Image size 2048x1536:
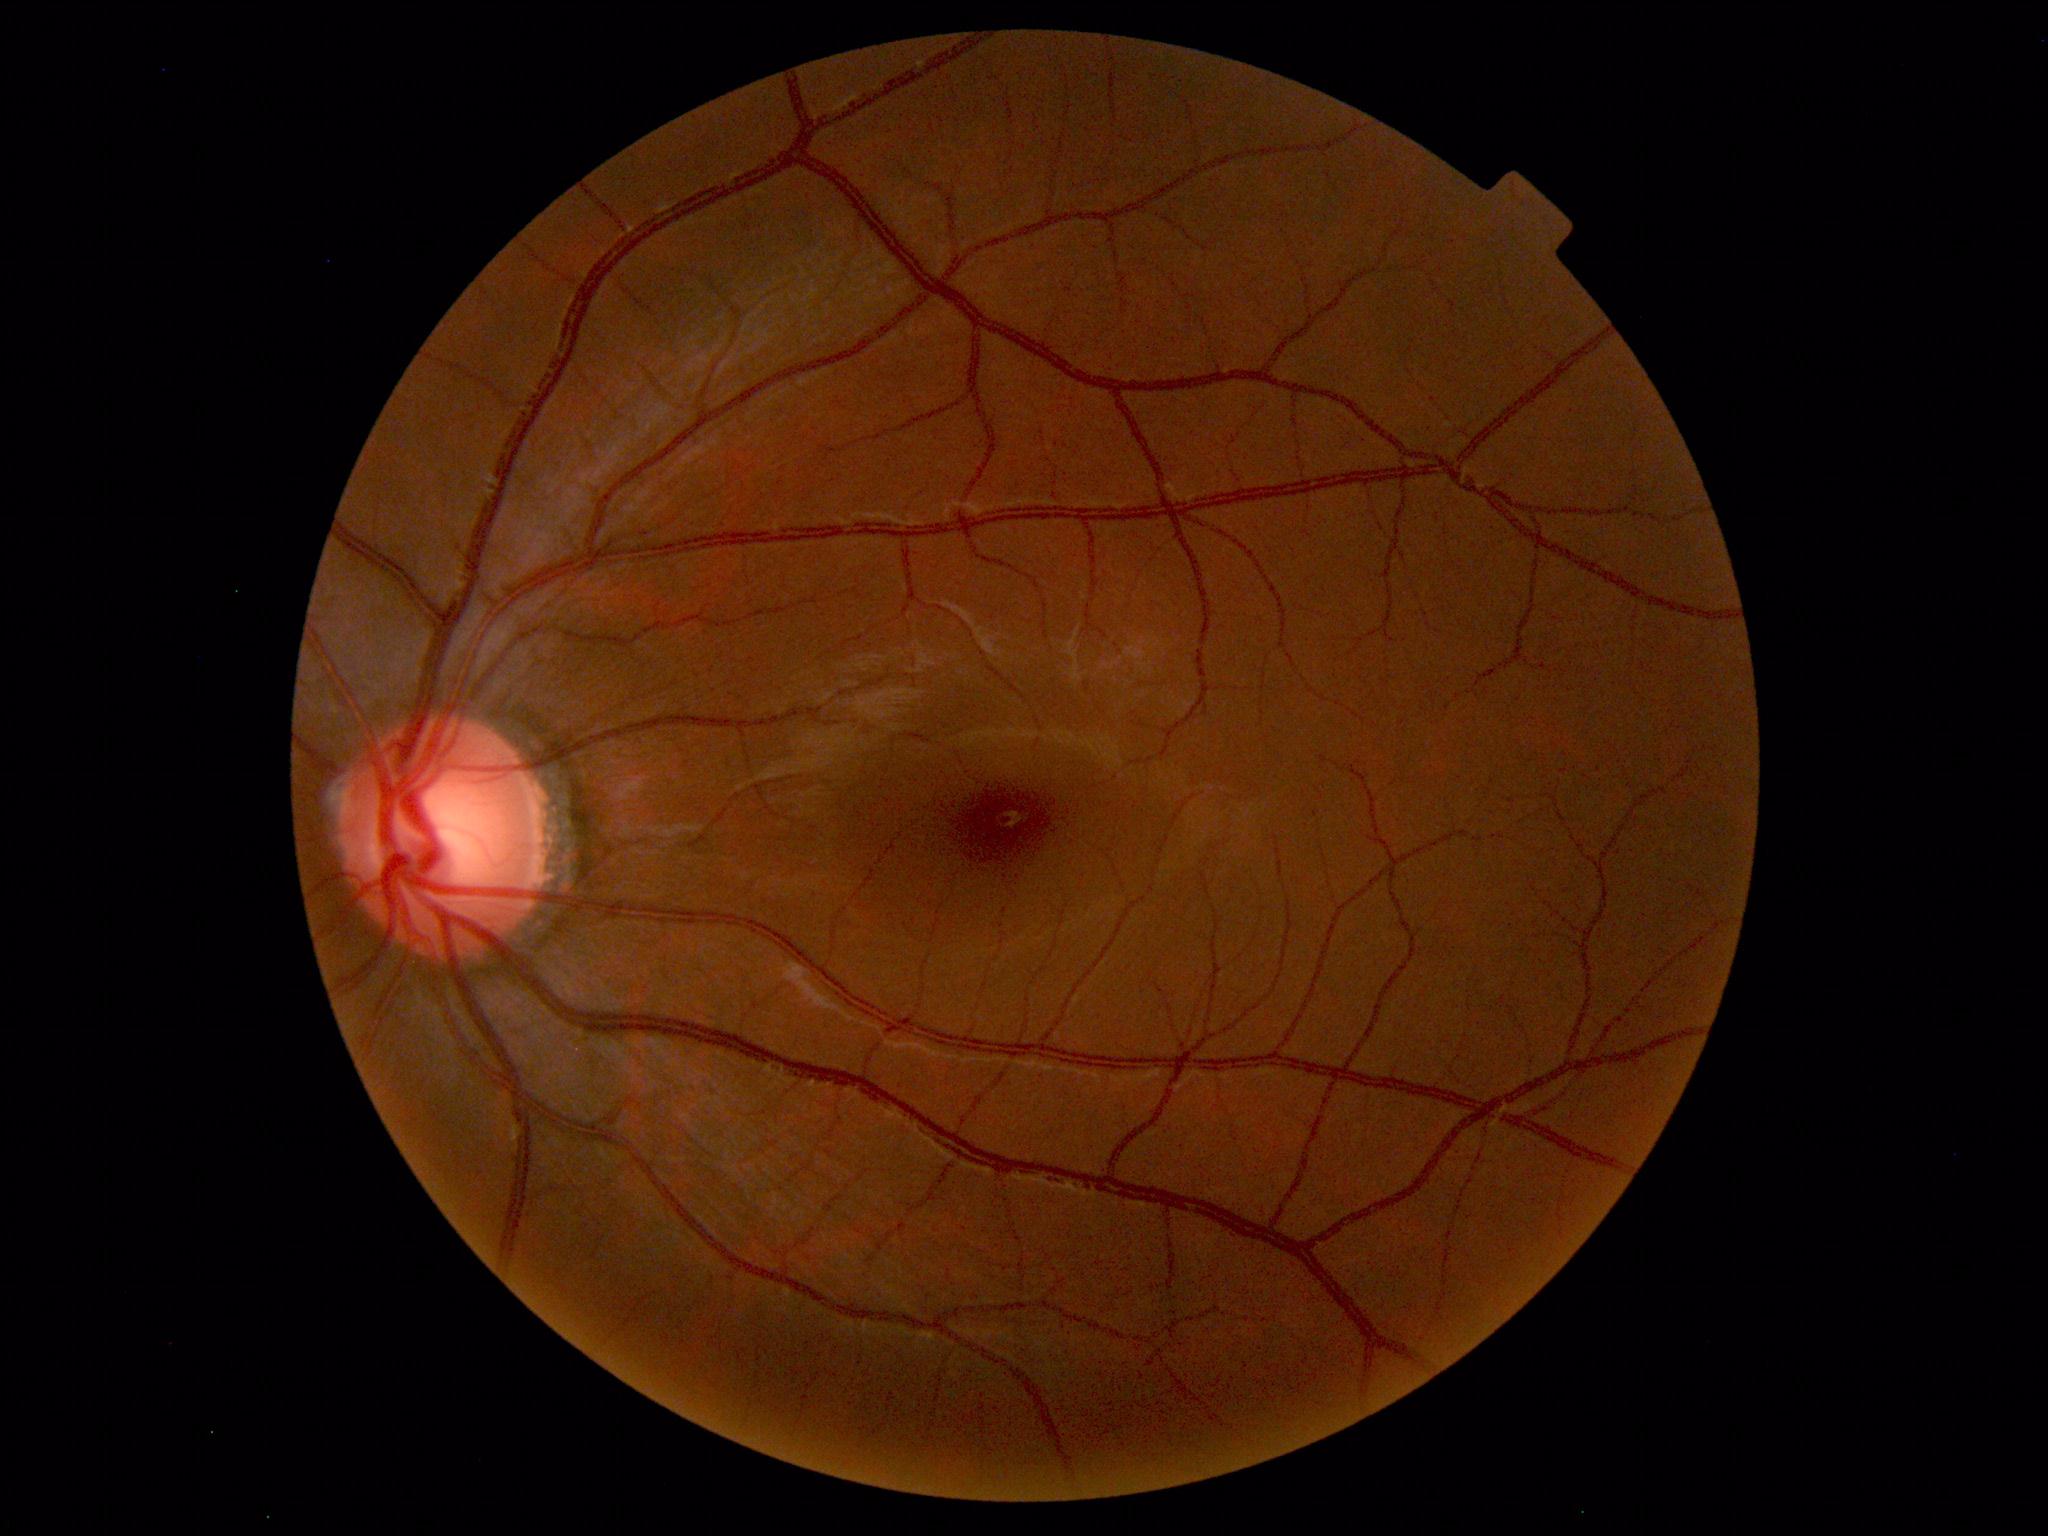

Normal retinal fundus image with no abnormalities identified.